Captured without pupil dilation; cropped to the optic nerve head
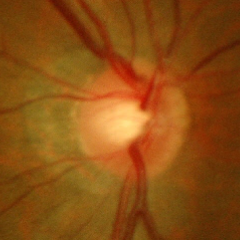

There is evidence of early glaucomatous changes.